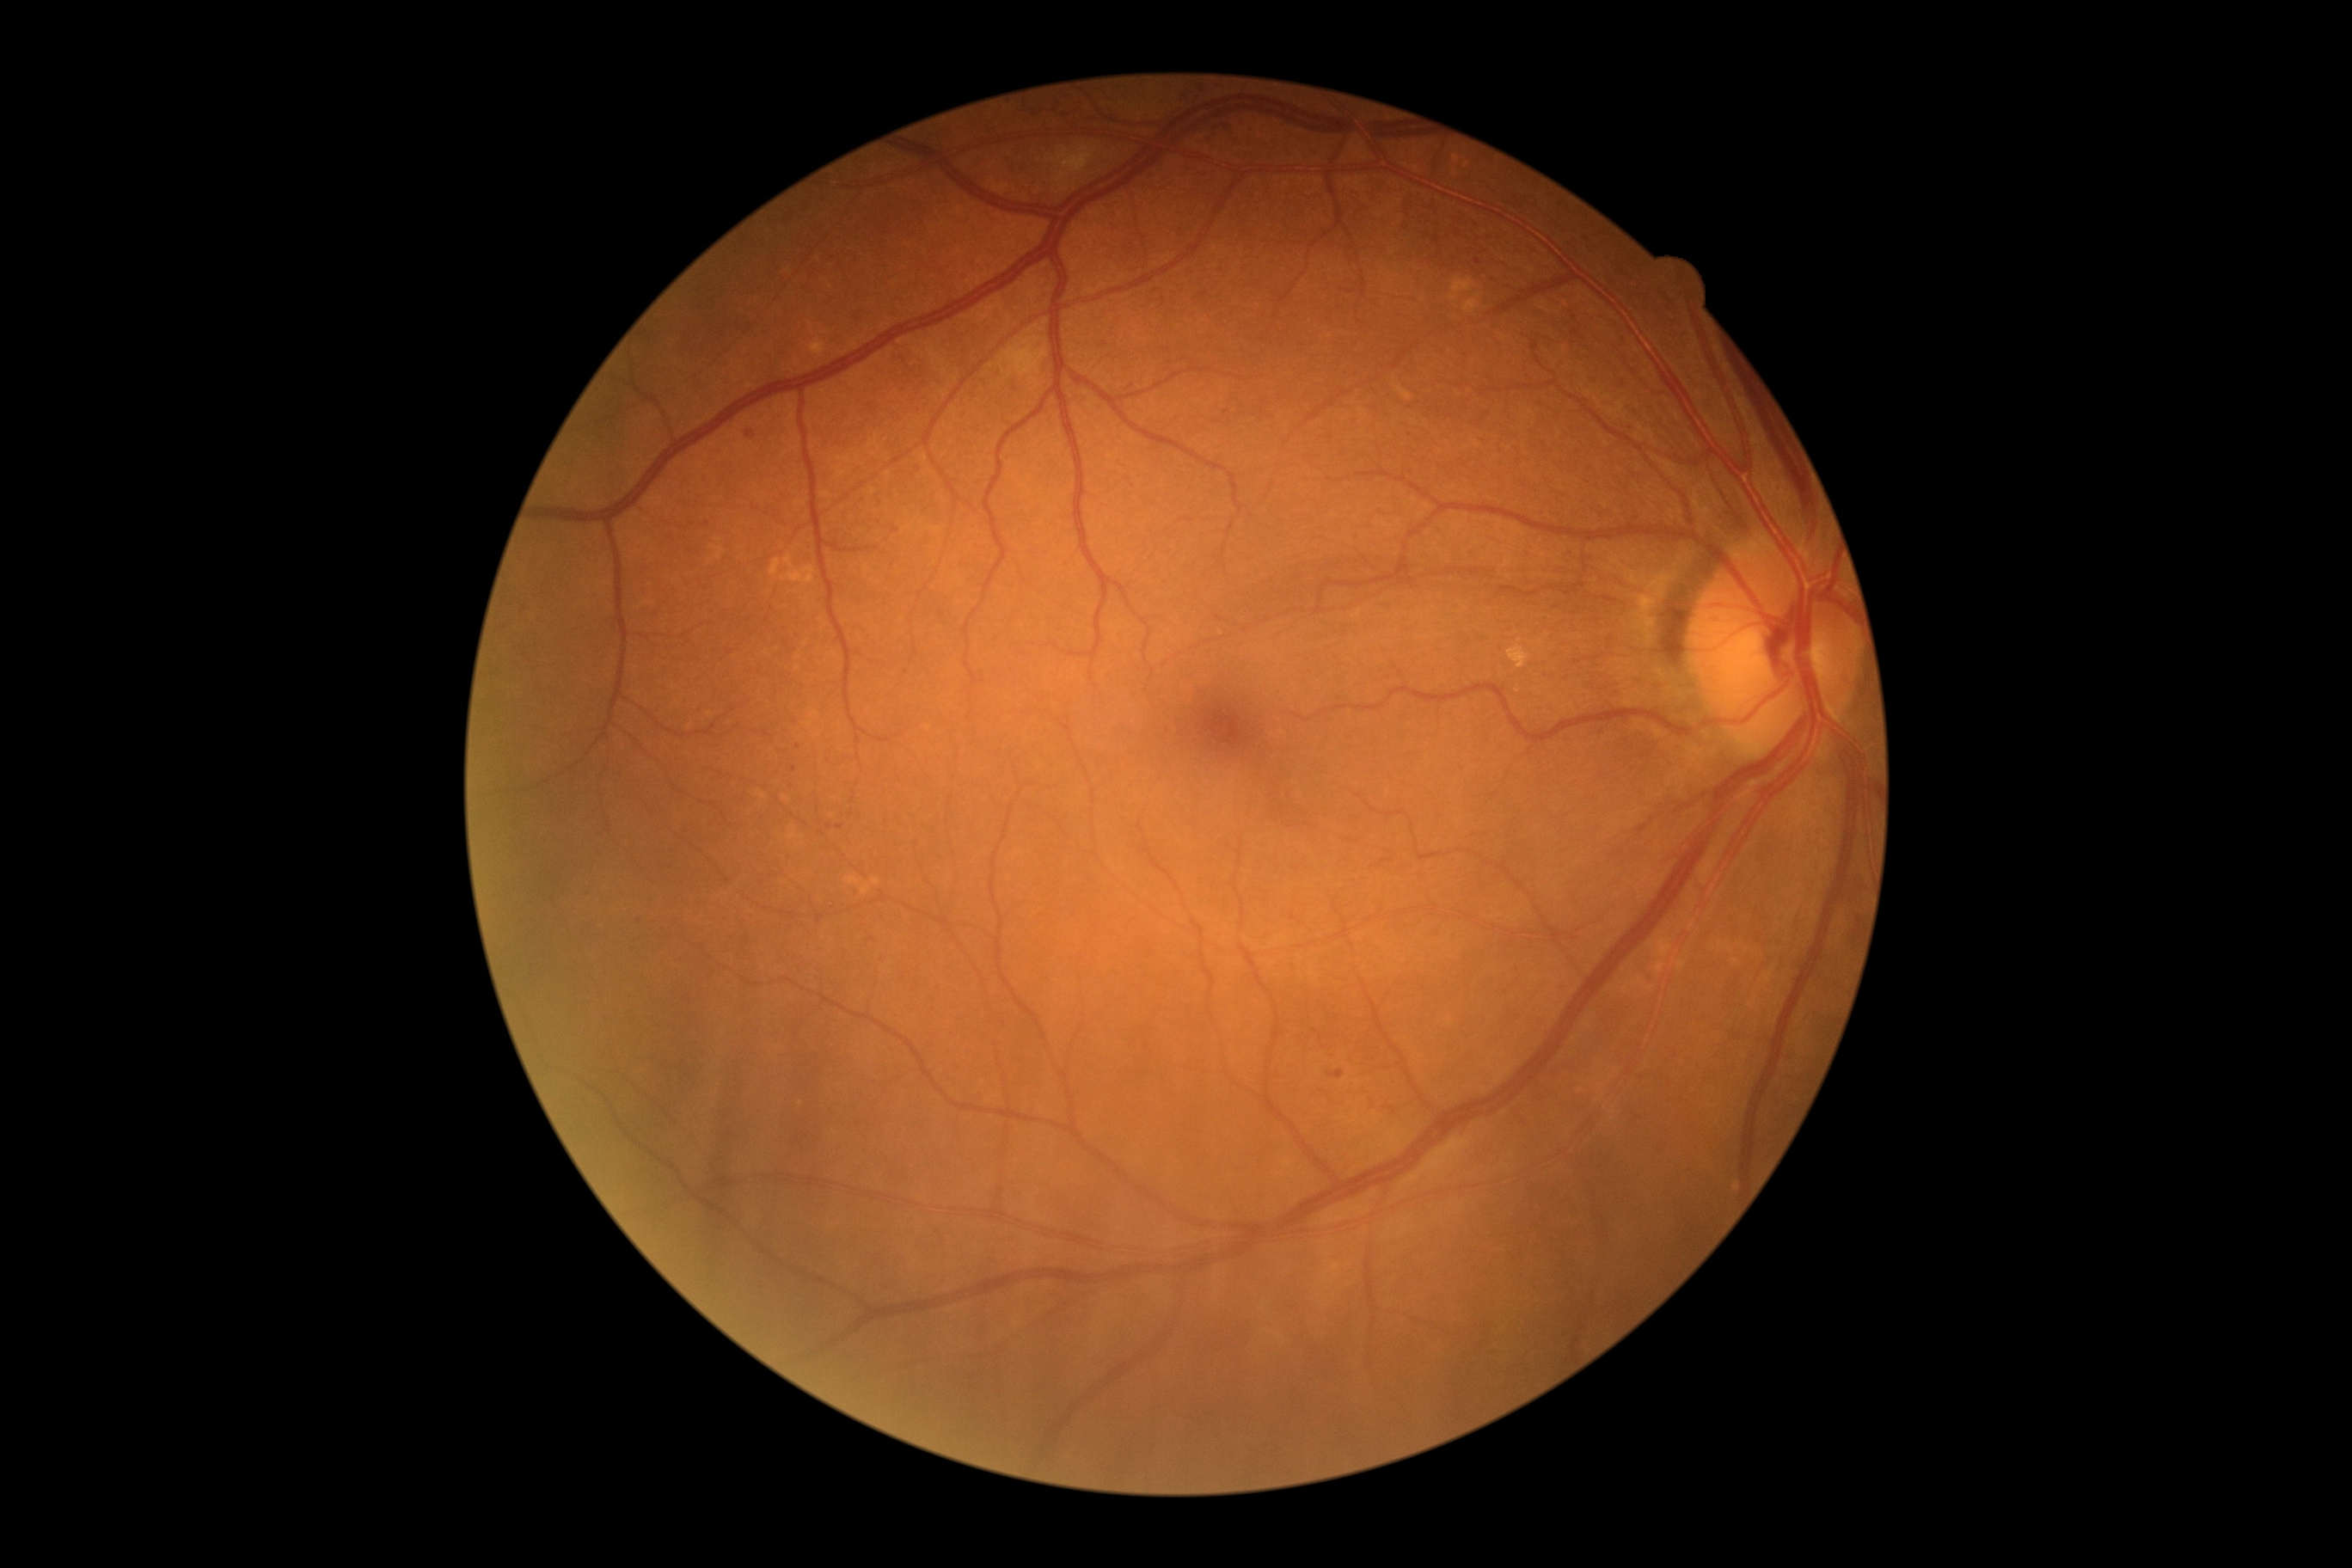 DR@moderate NPDR (grade 2).